Color fundus image — 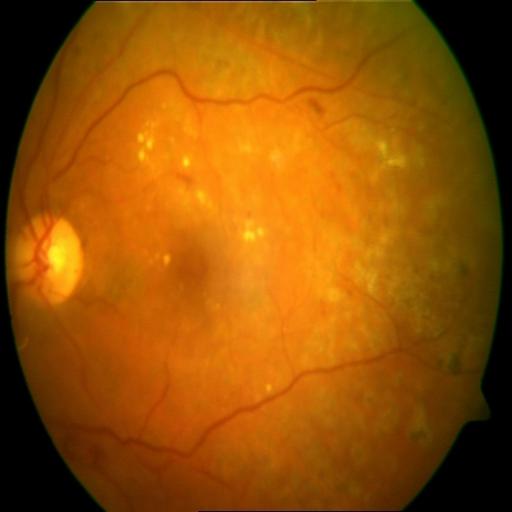 Showing laser scars & exudation.